Cropped to the optic nerve head. Acquired with a Nidek AFC-330 — 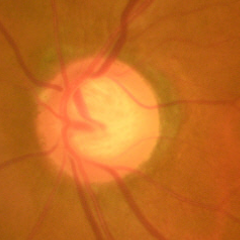 Fundus image with findings of early-stage glaucoma.